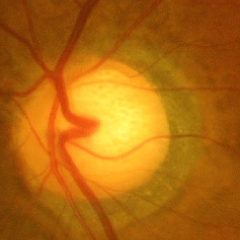 The image shows advanced glaucomatous optic neuropathy. Defined as near-total cupping of the optic nerve head, with or without severe visual field loss within the central 10 degrees of fixation.